Topcon TRC-NW8: 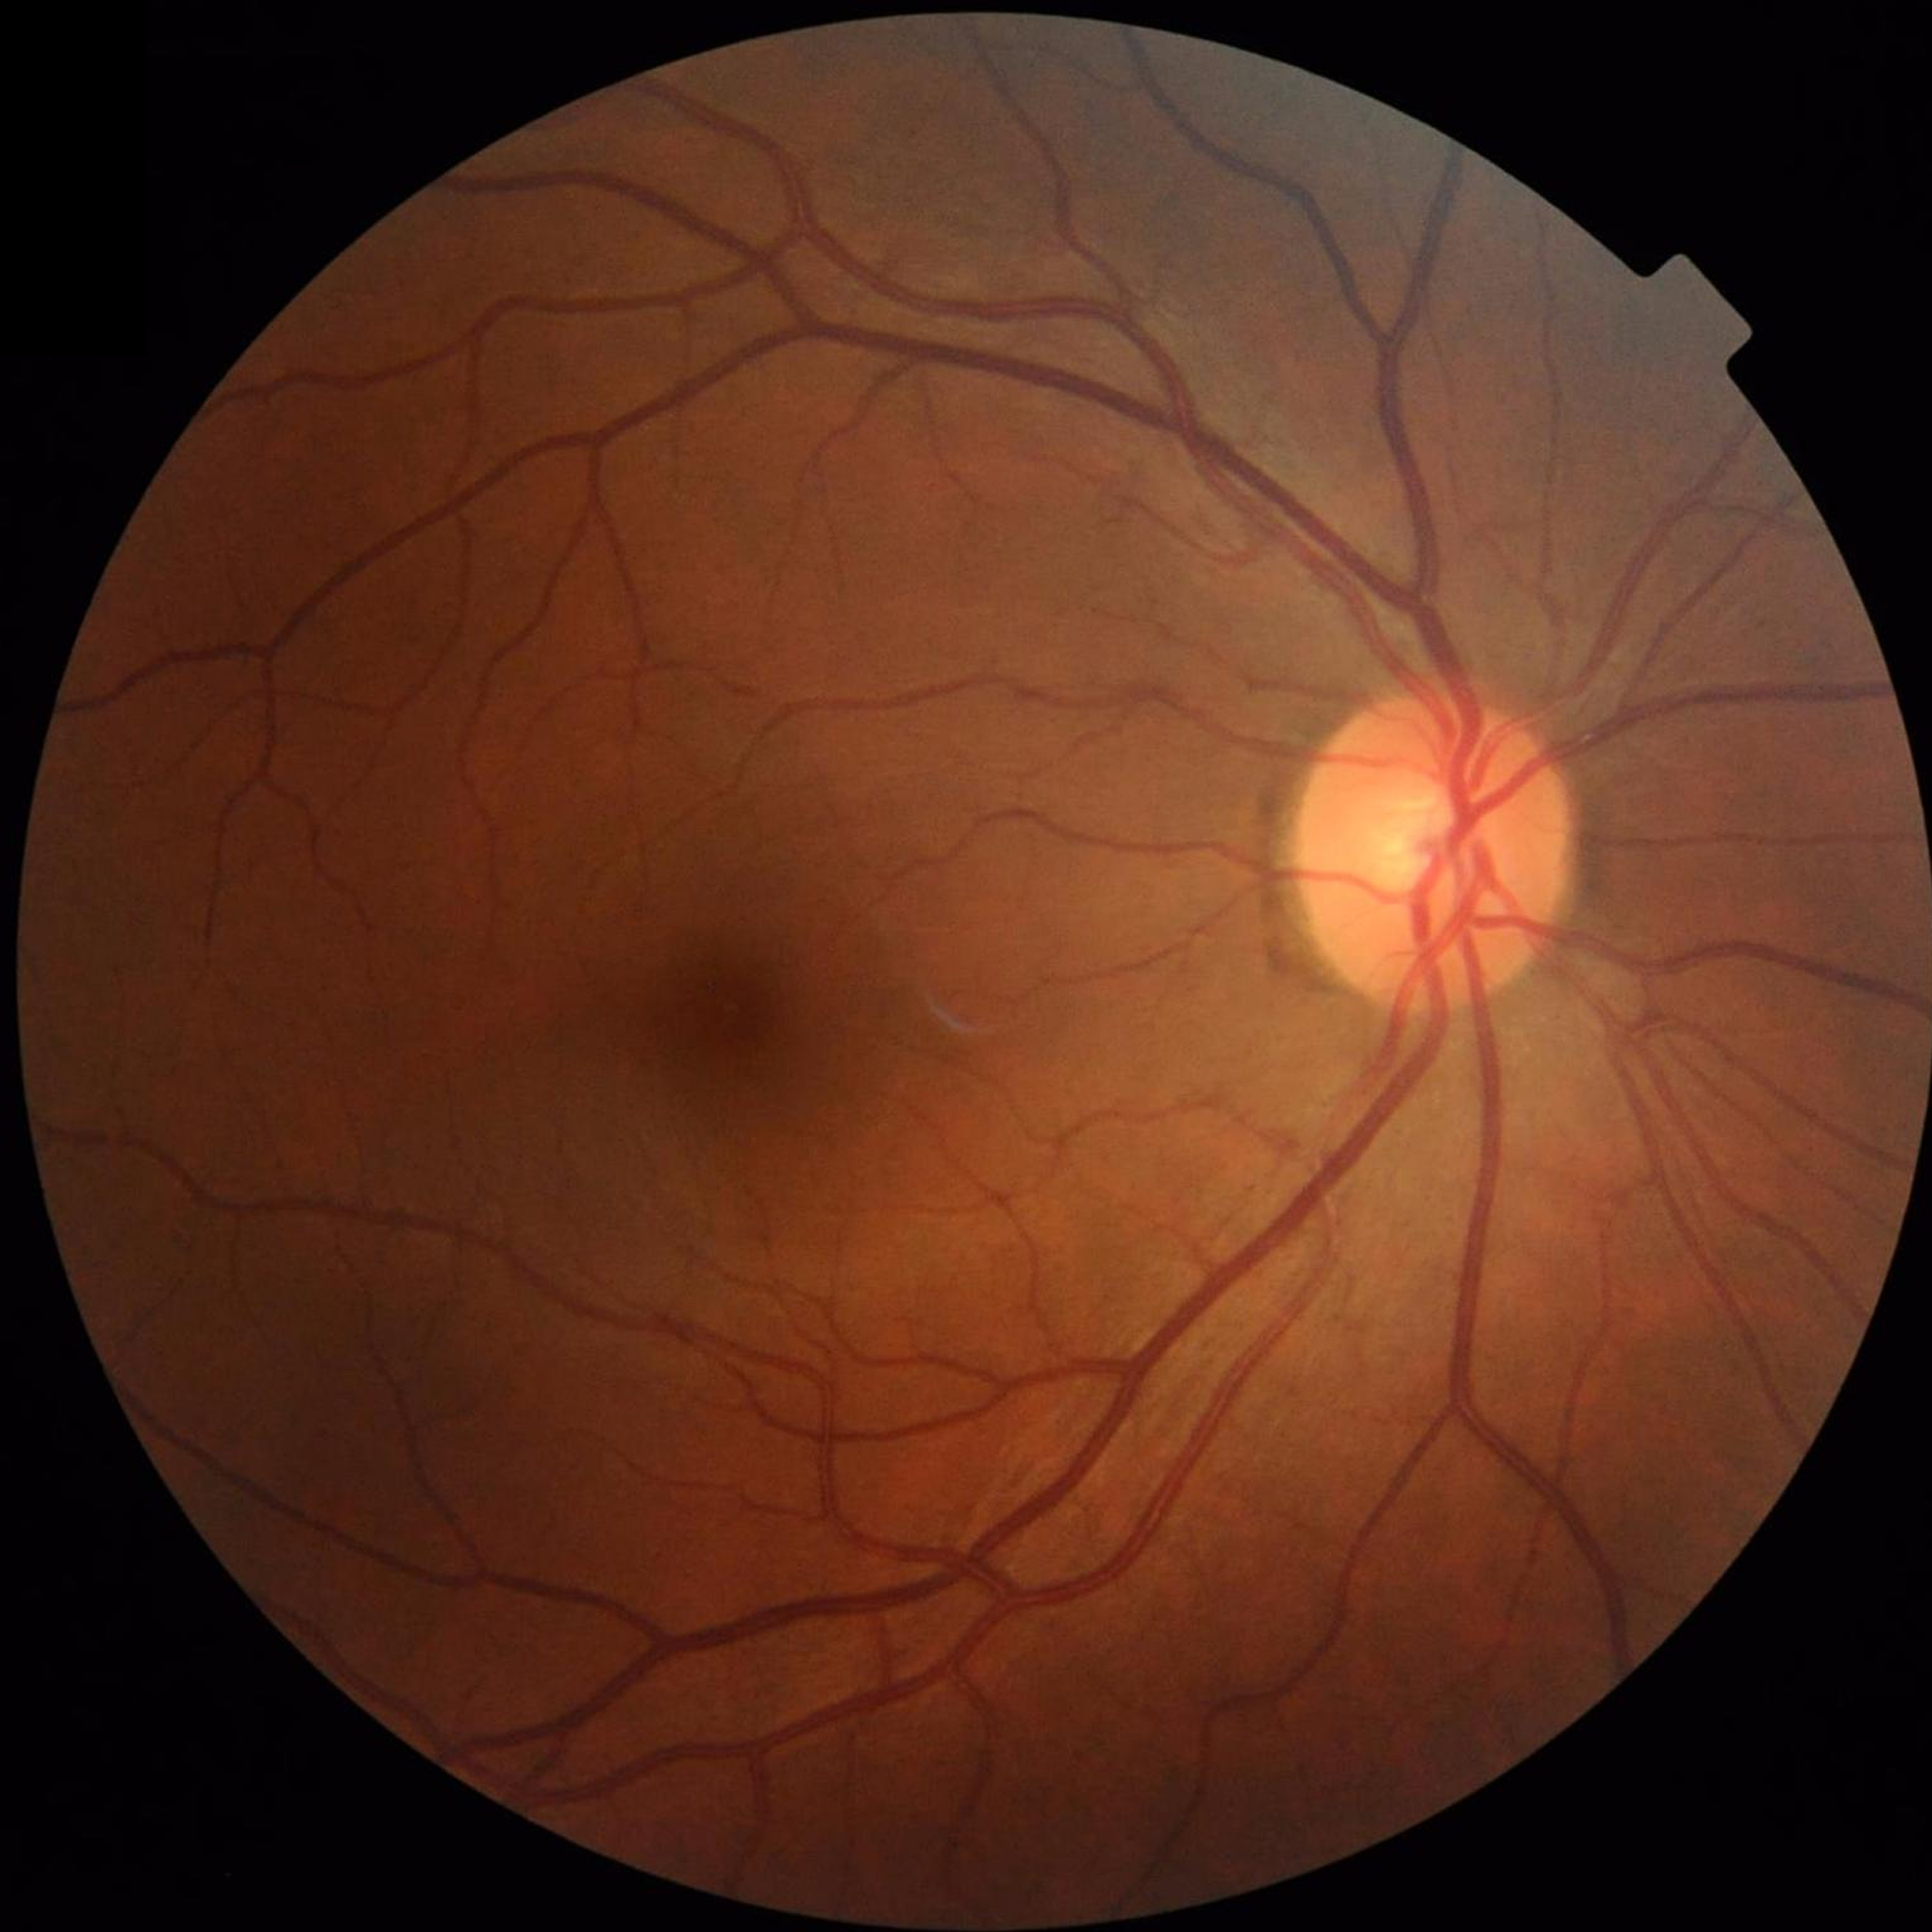
diagnosis: control (no AMD/DR/glaucoma)